Acquired on the Natus RetCam Envision; RetCam wide-field infant fundus image; 1440x1080px:
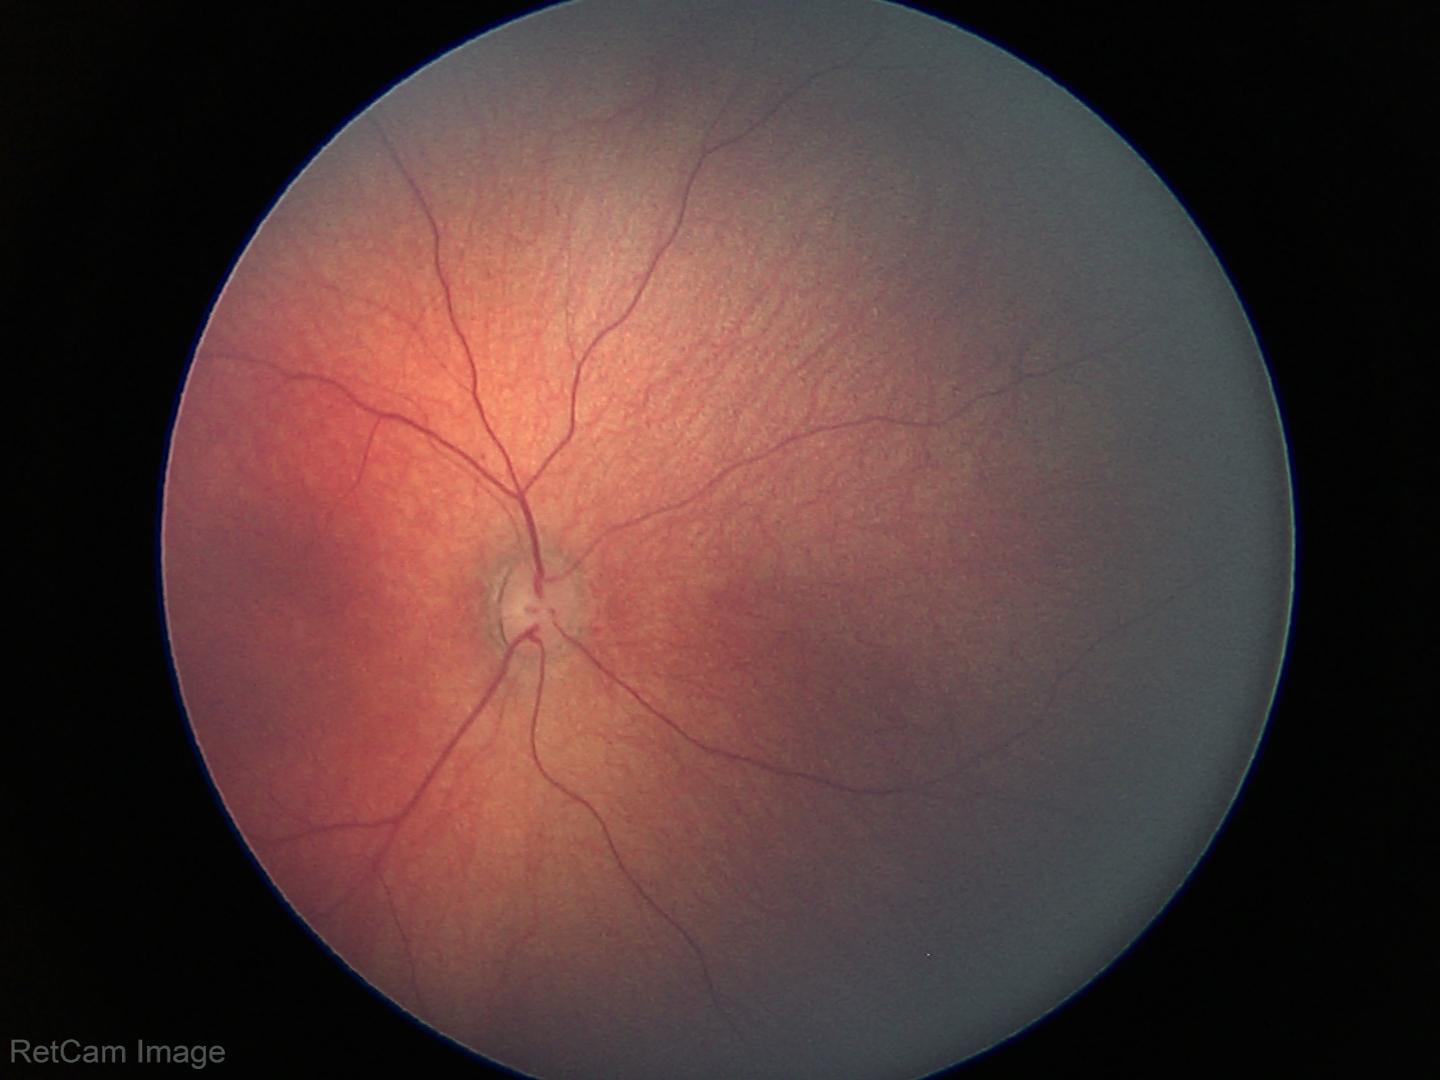
Assessment = physiological.